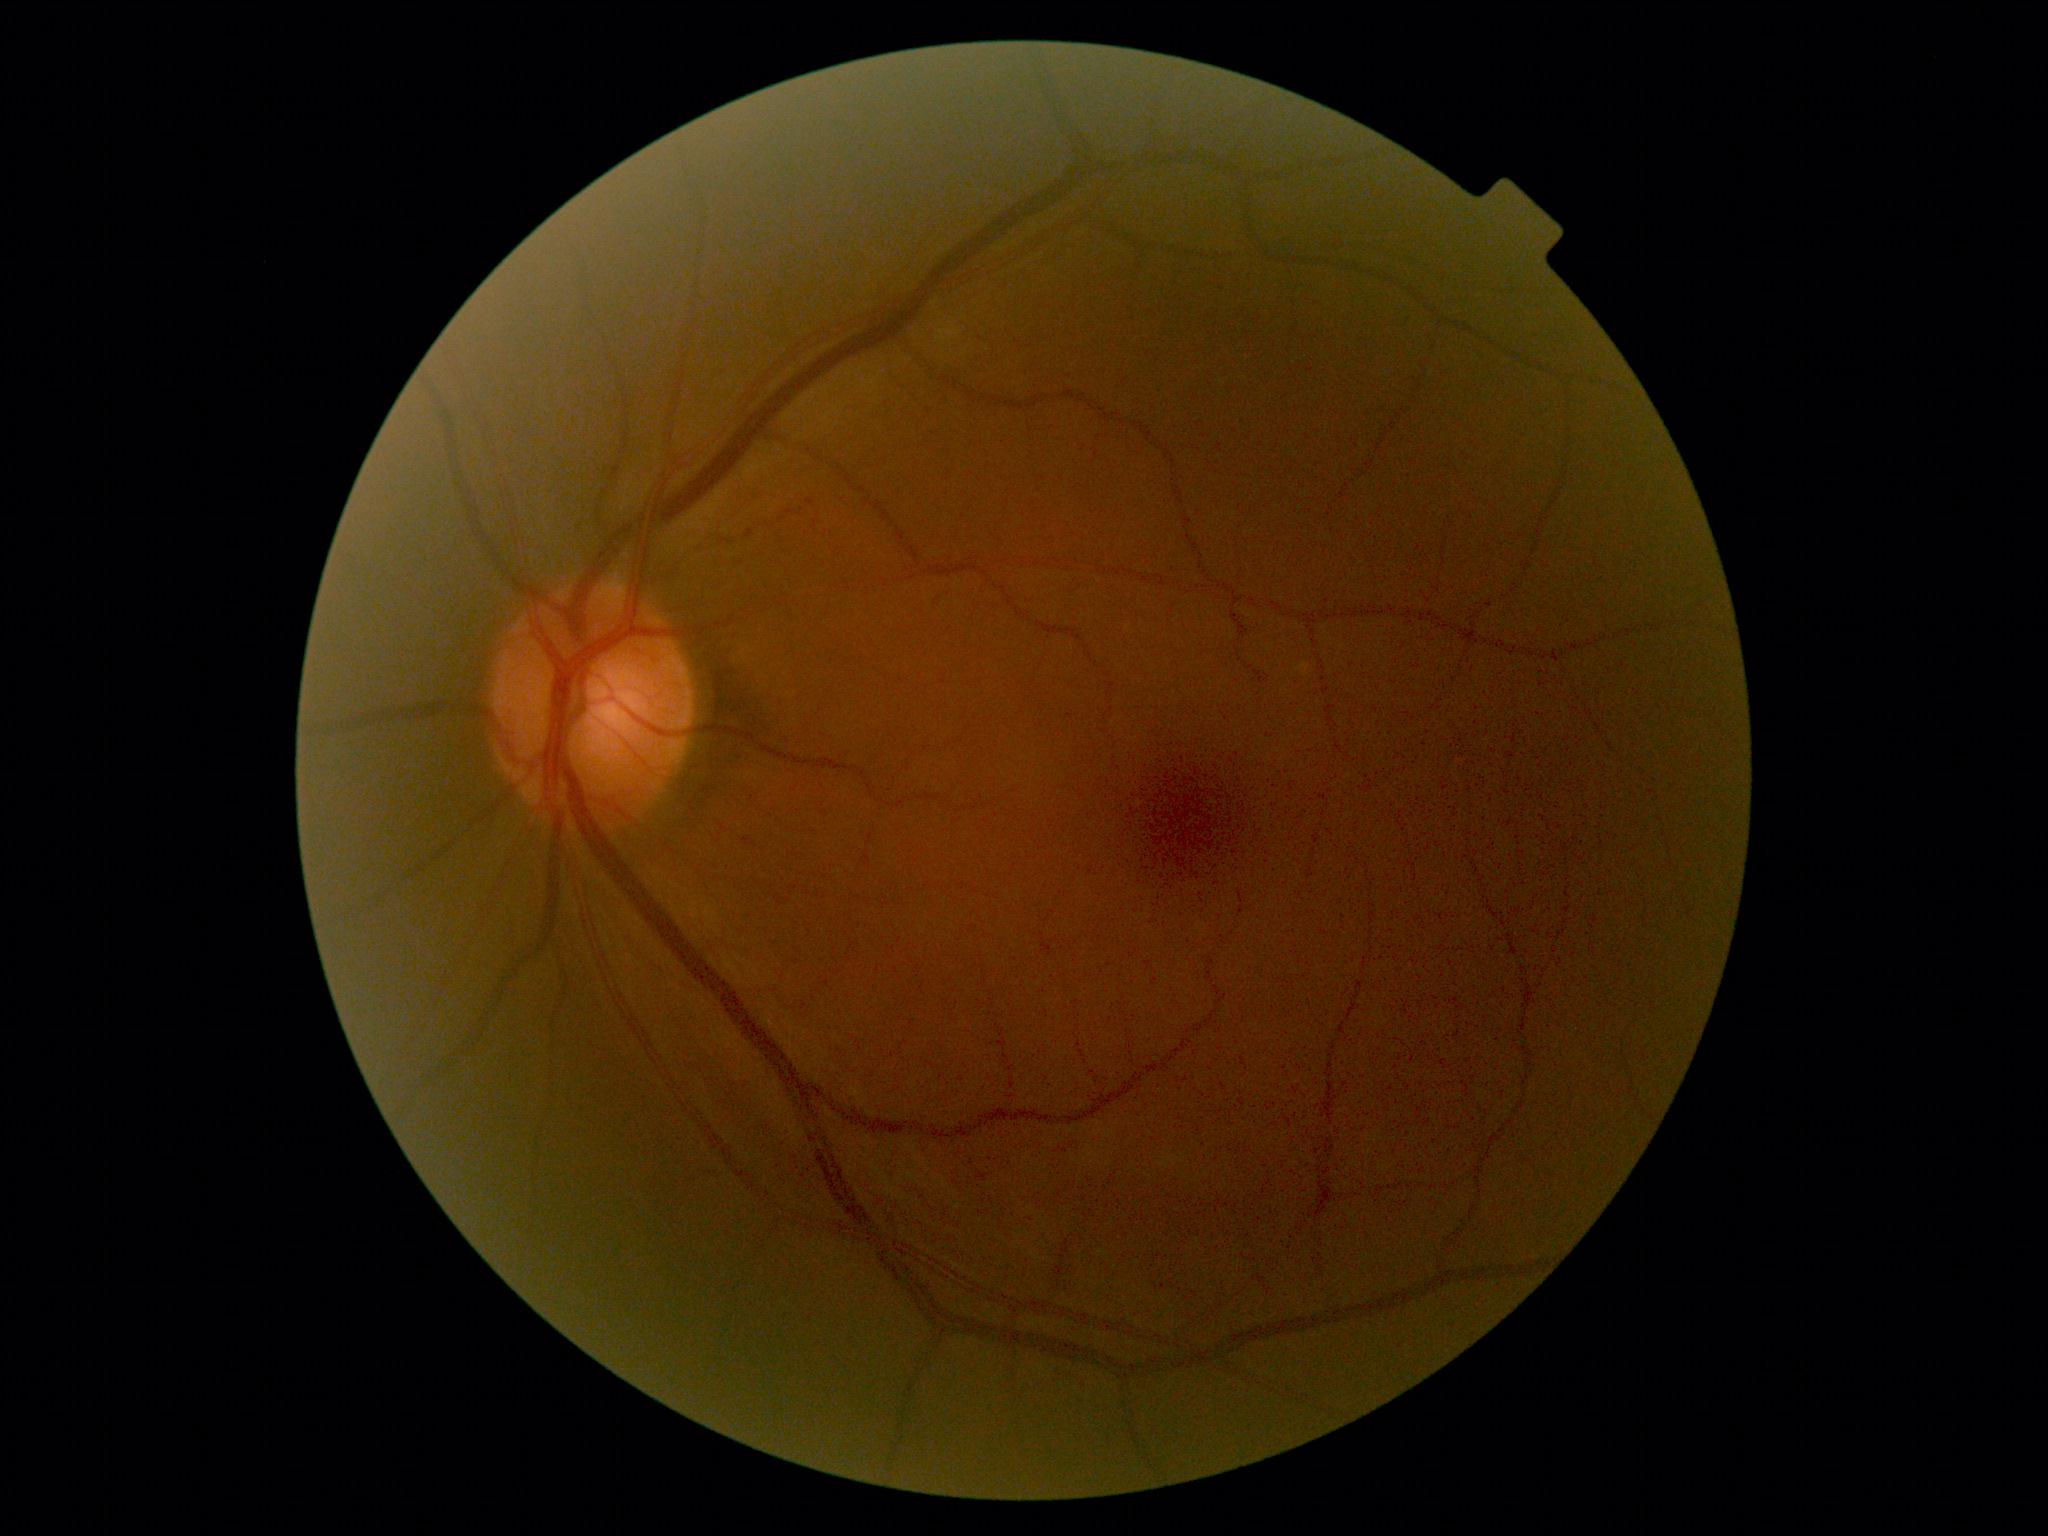
Diabetic retinopathy grade is 0. No DR findings.